45° field of view.
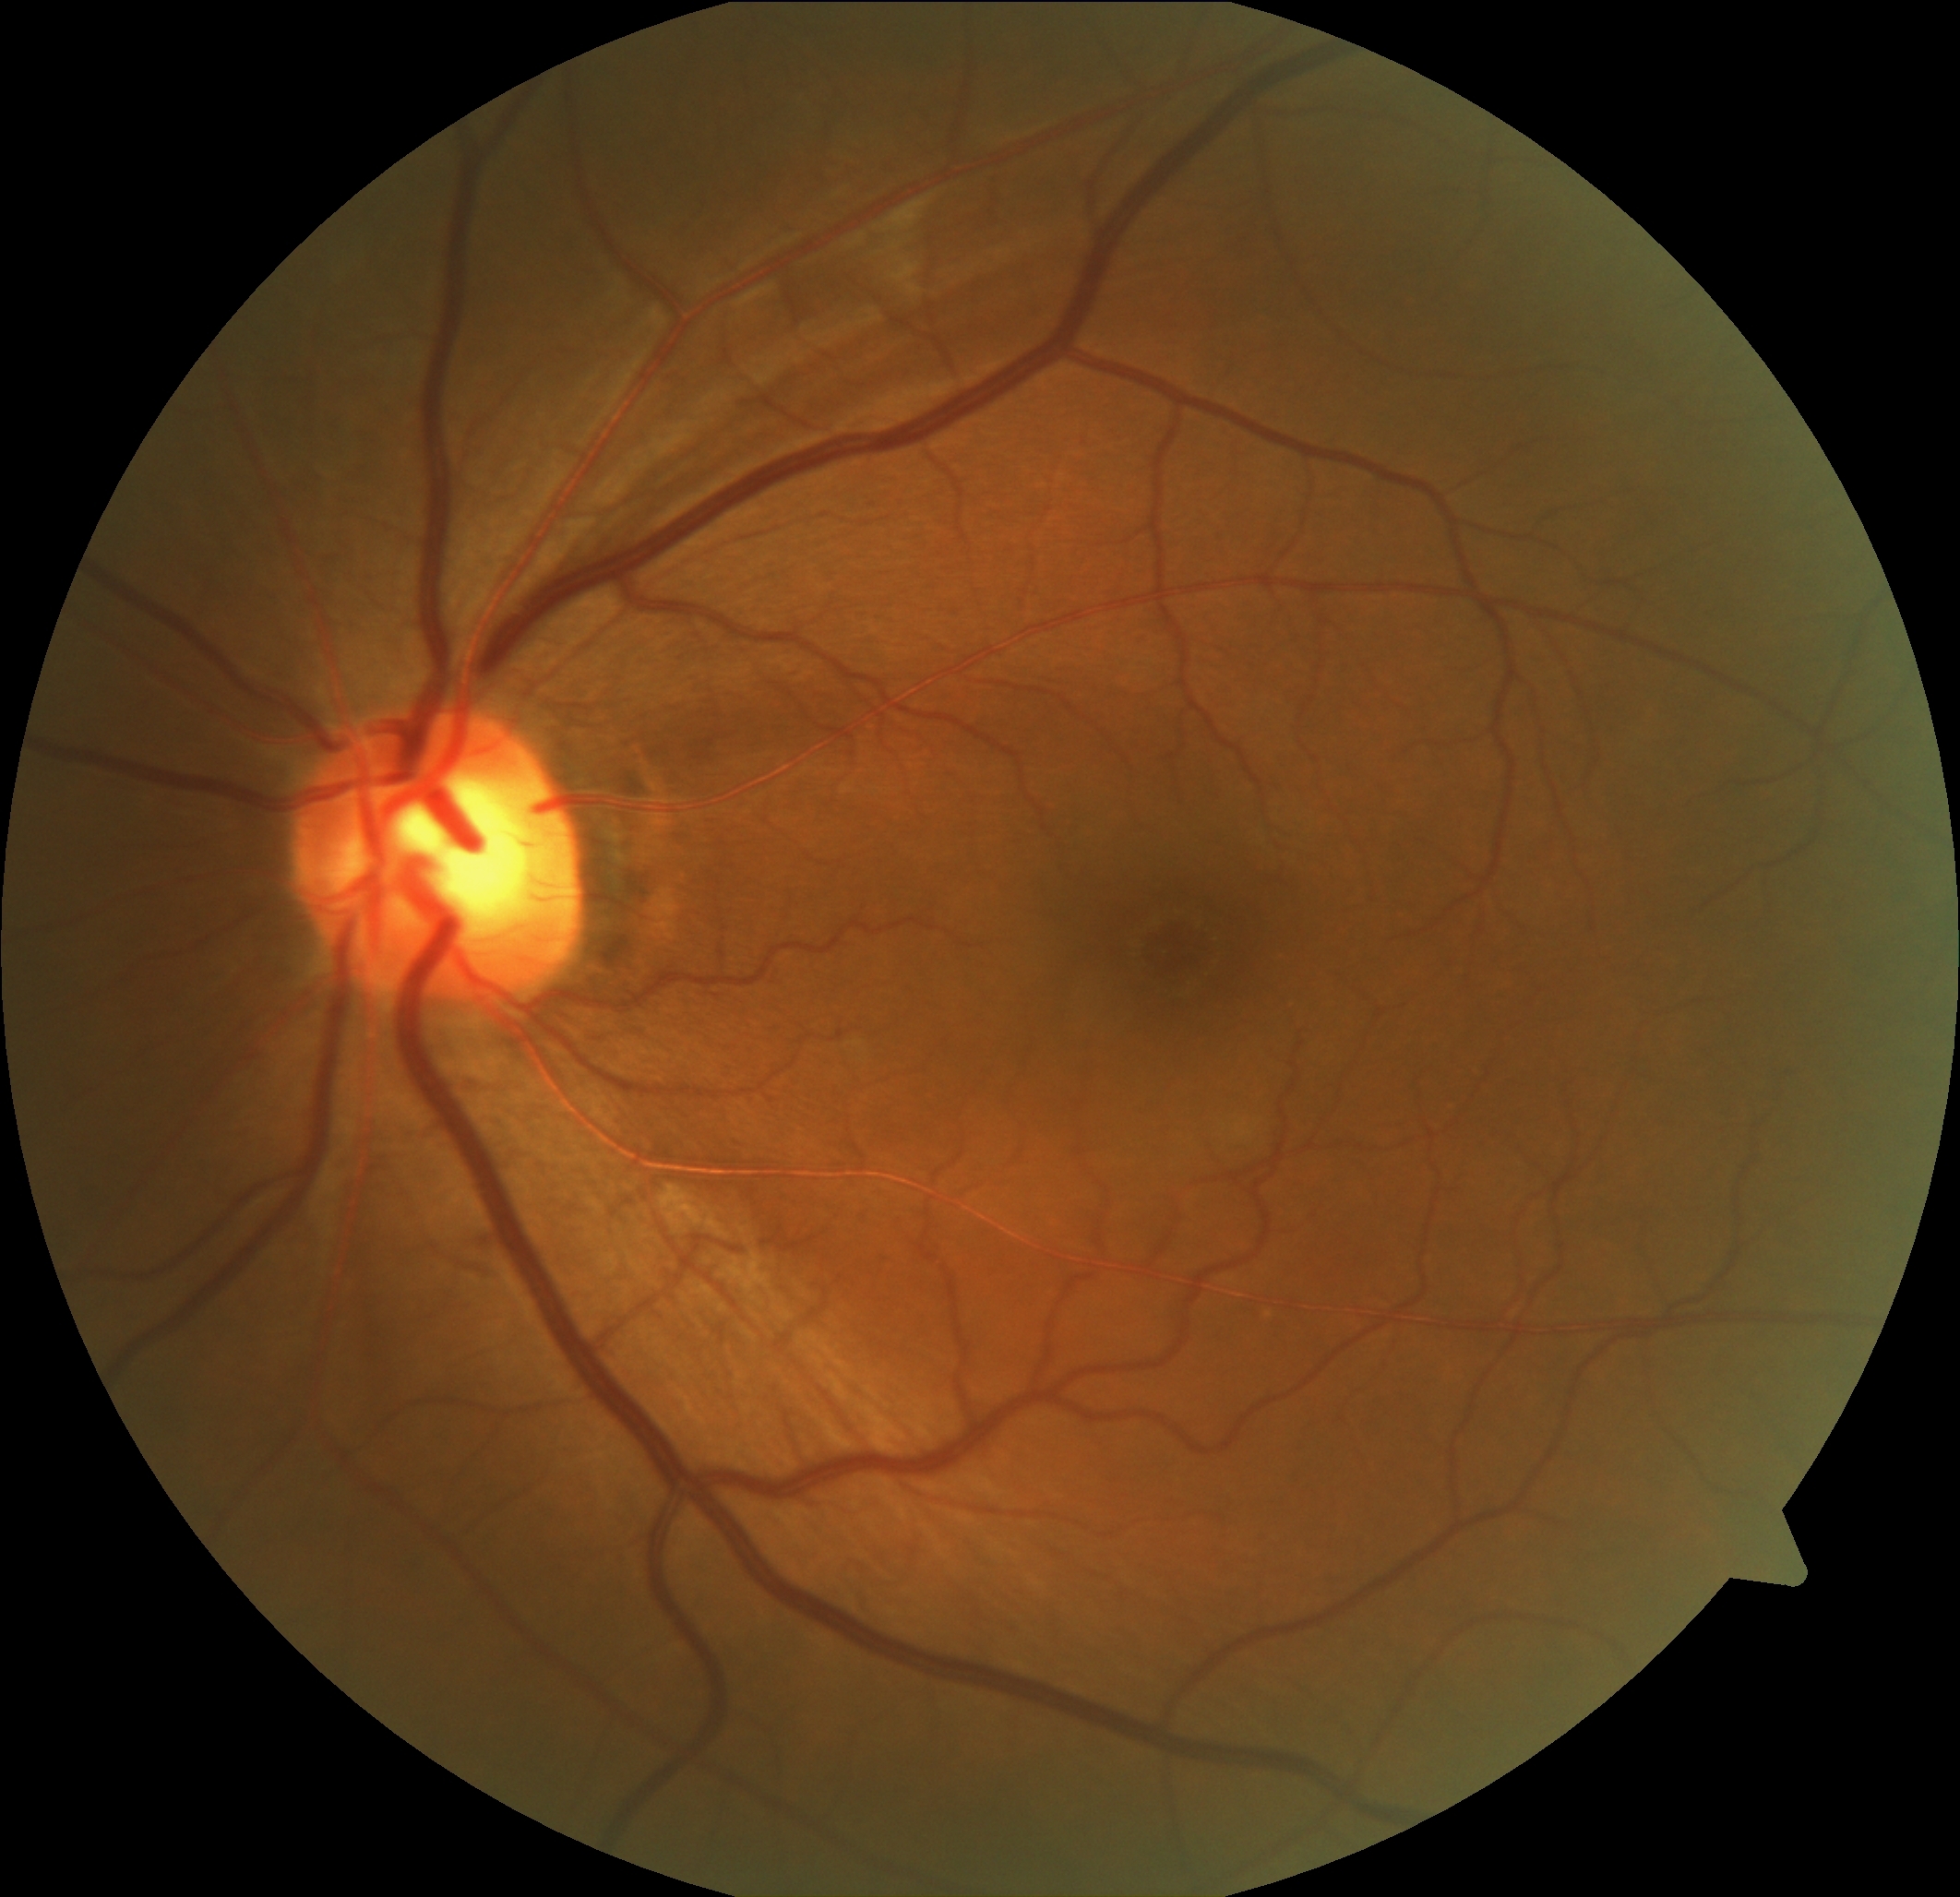
Diabetic retinopathy grade is 0 (no apparent retinopathy) — no visible signs of diabetic retinopathy.